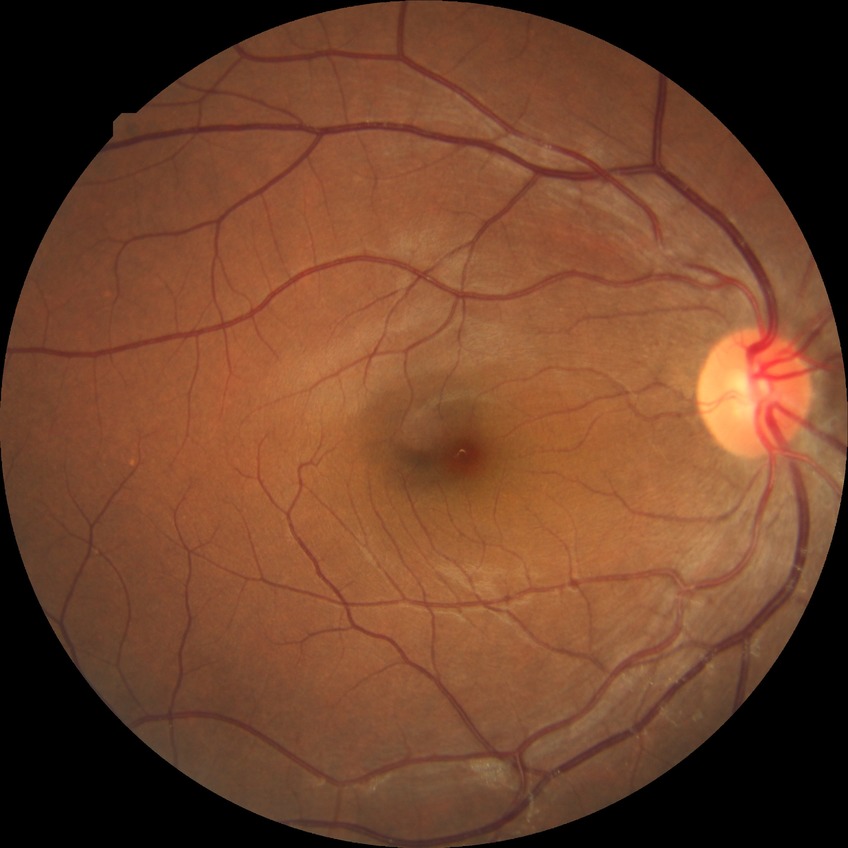   davis_grade: no diabetic retinopathy